Modified Davis classification:
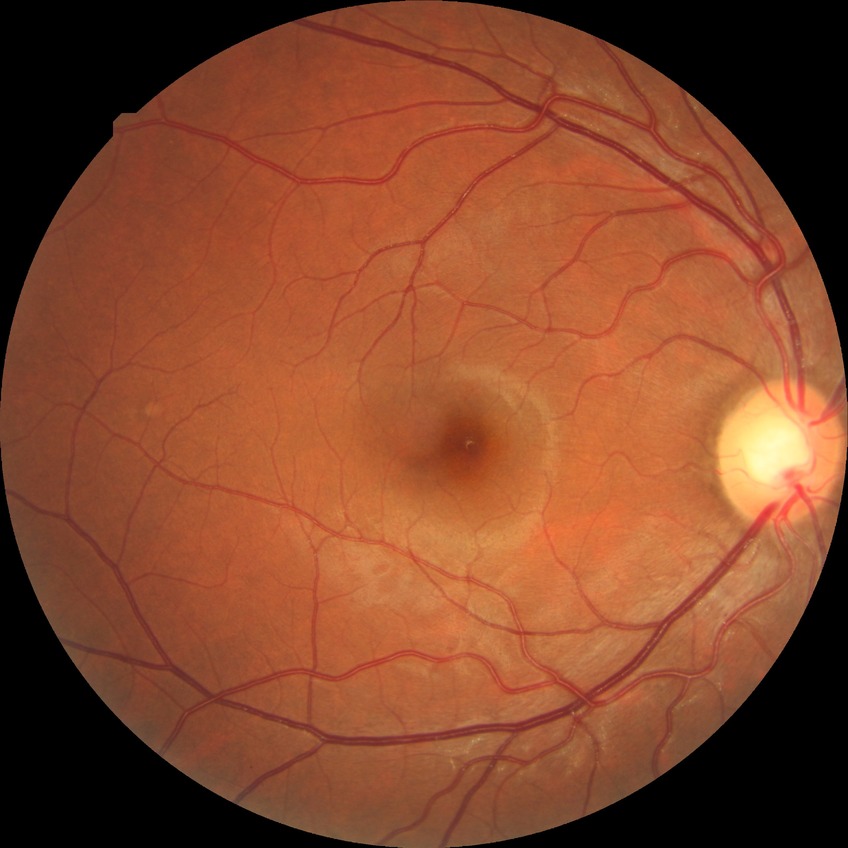

diabetic retinopathy (DR)=no diabetic retinopathy (NDR).